Retinal fundus photograph
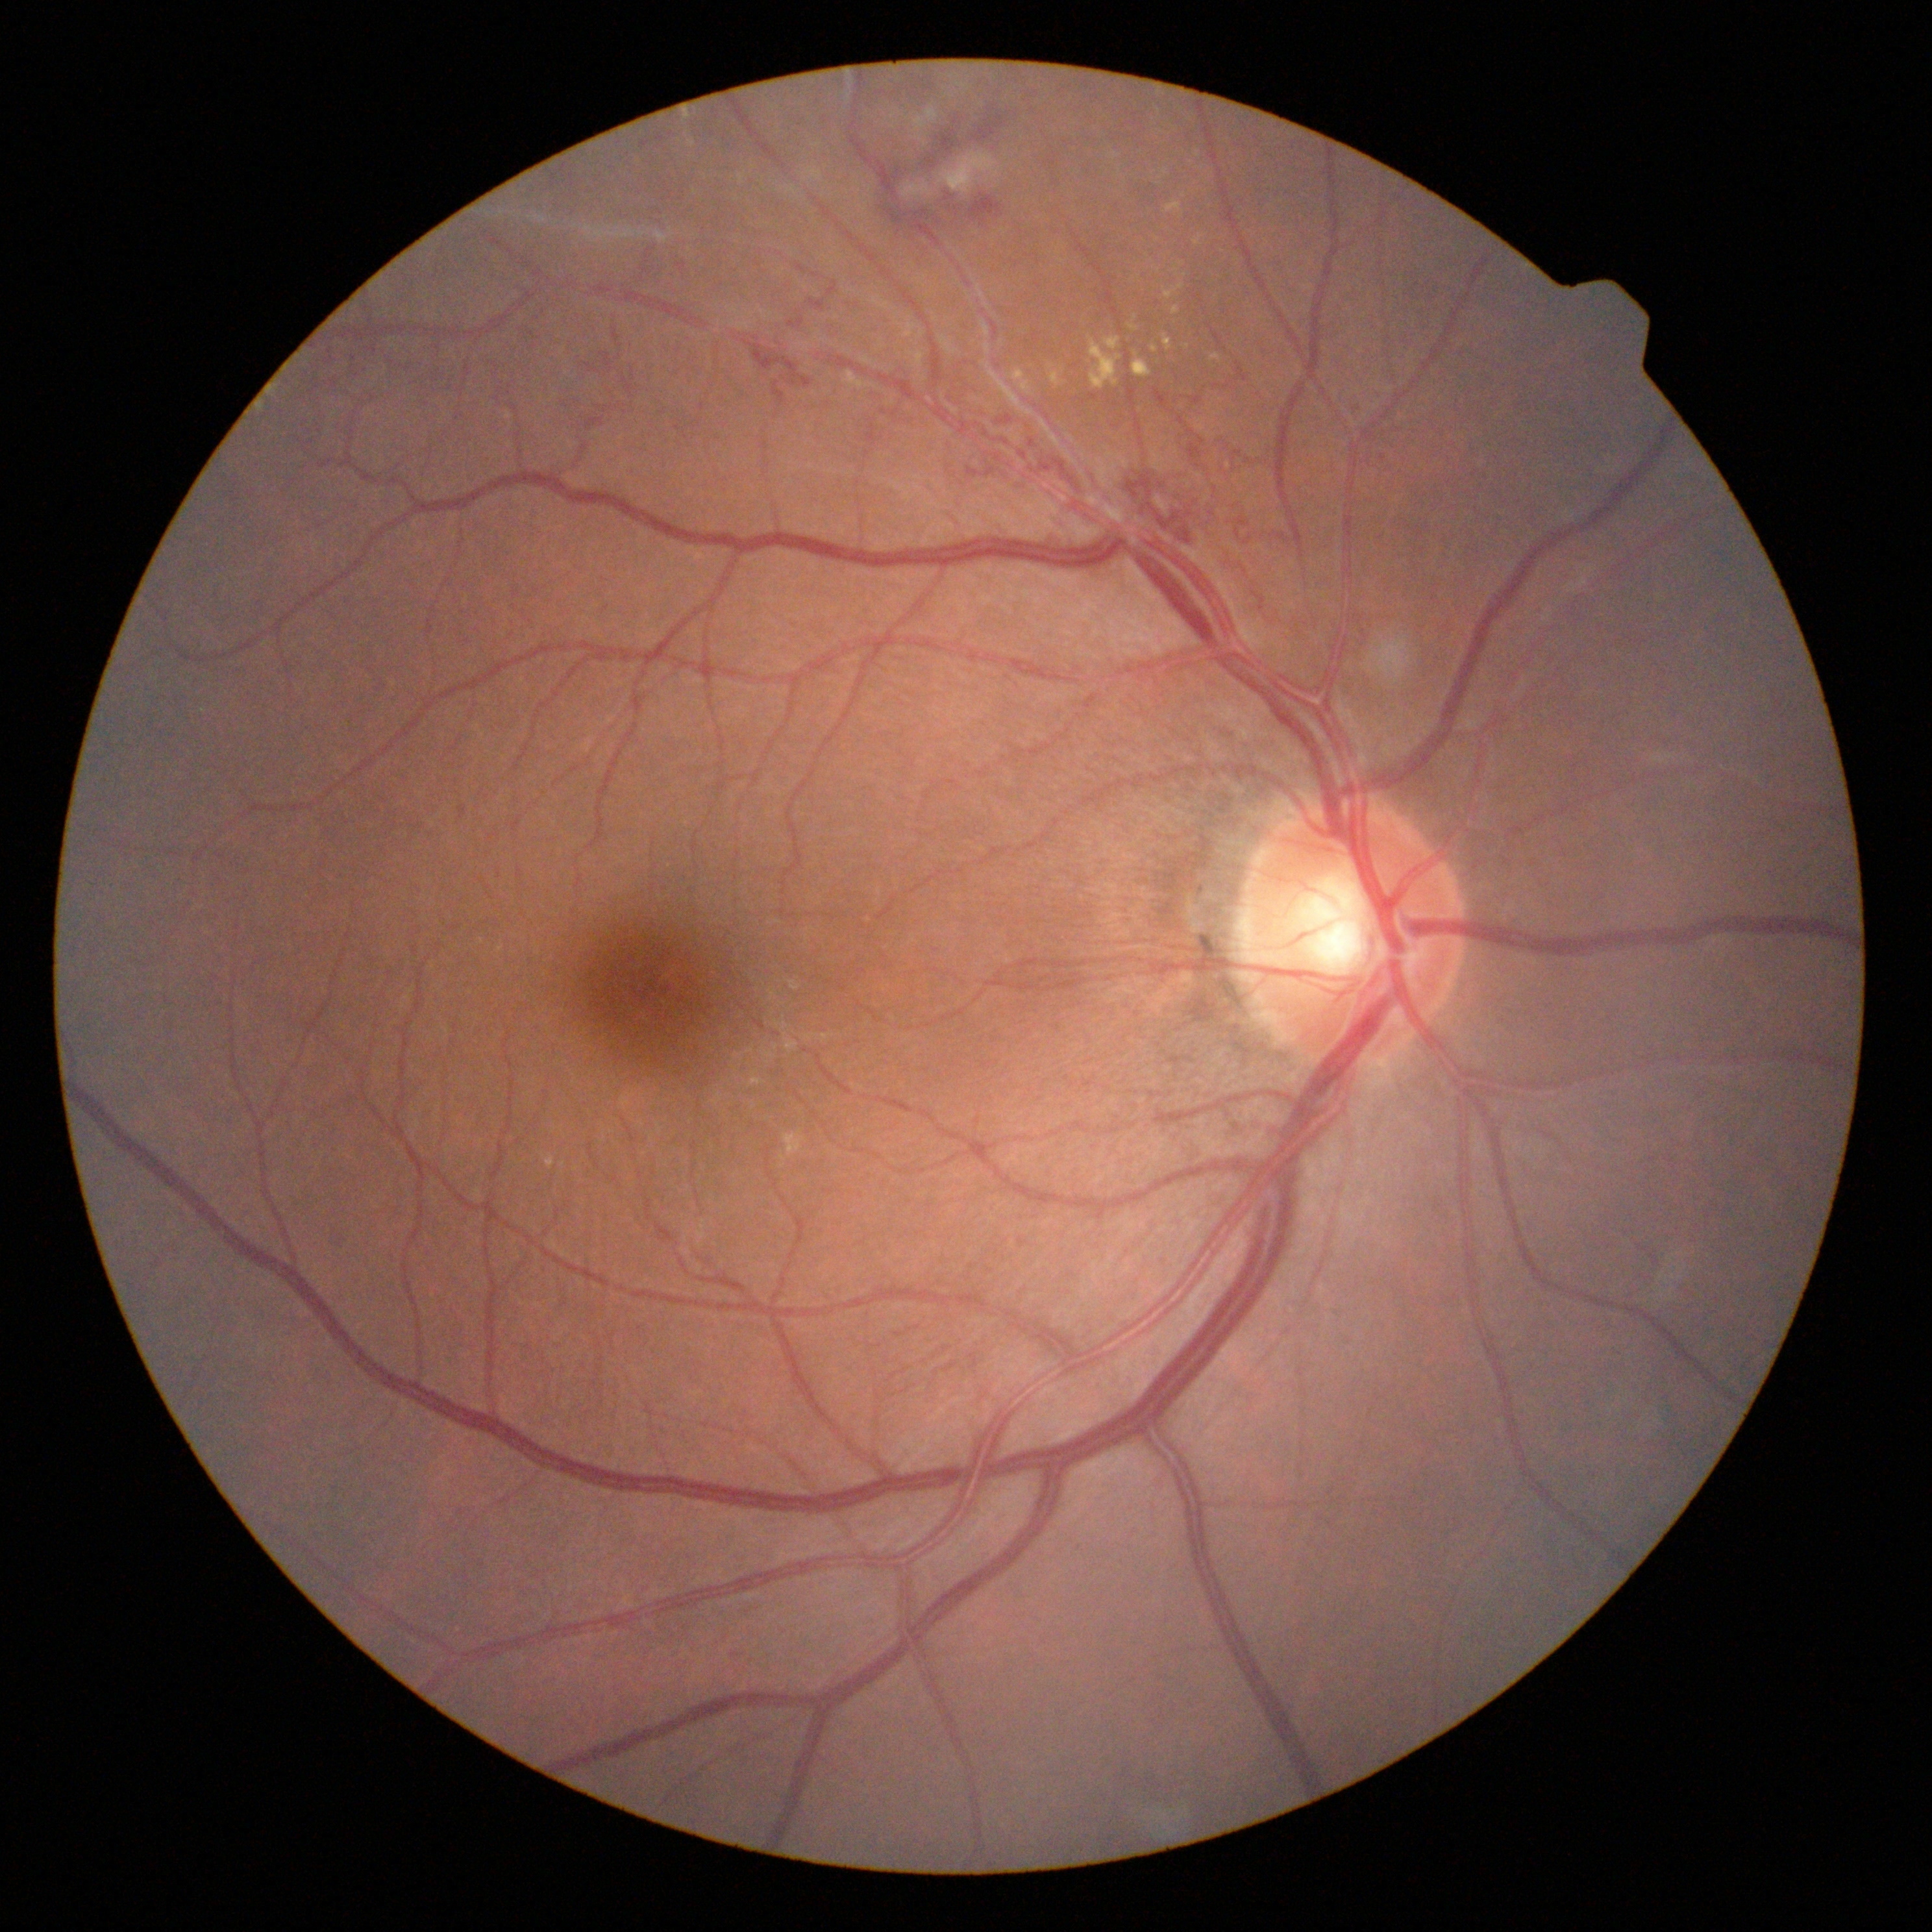 Annotations:
• diabetic retinopathy (DR) — severe NPDR (grade 3) — more than 20 intraretinal hemorrhages in each of 4 quadrants, definite venous beading in 2 or more quadrants, or prominent intraretinal microvascular abnormalities in 1 or more quadrants, with no signs of proliferative retinopathy